848 x 848 pixels; Davis DR grading; FOV: 45 degrees — 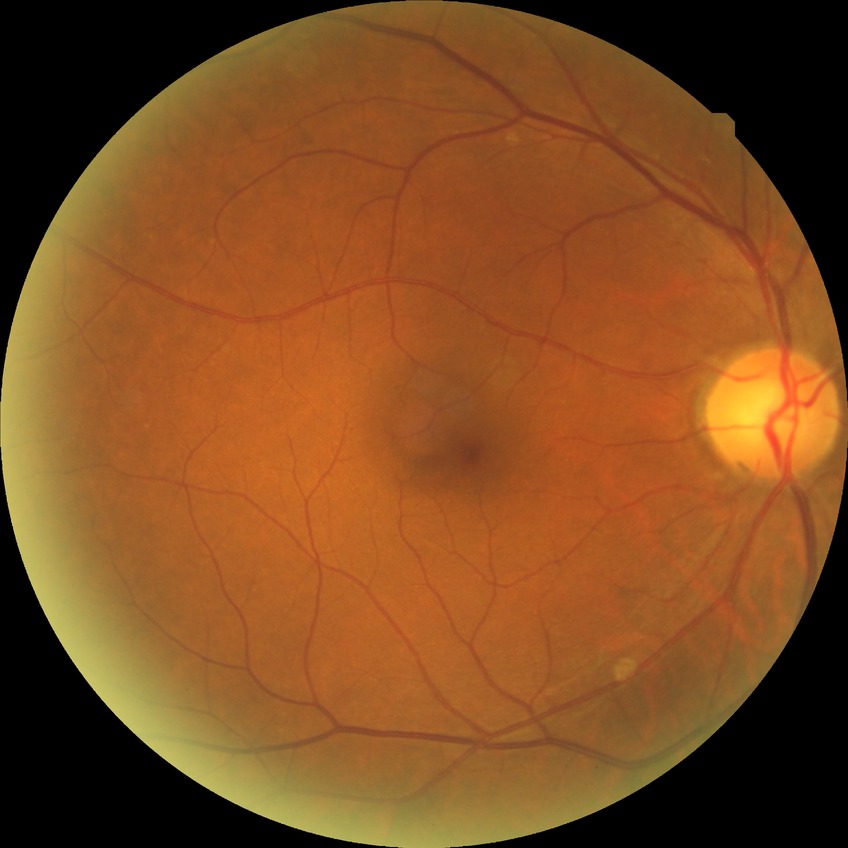

diabetic retinopathy (DR): no diabetic retinopathy (NDR).